Color fundus image — 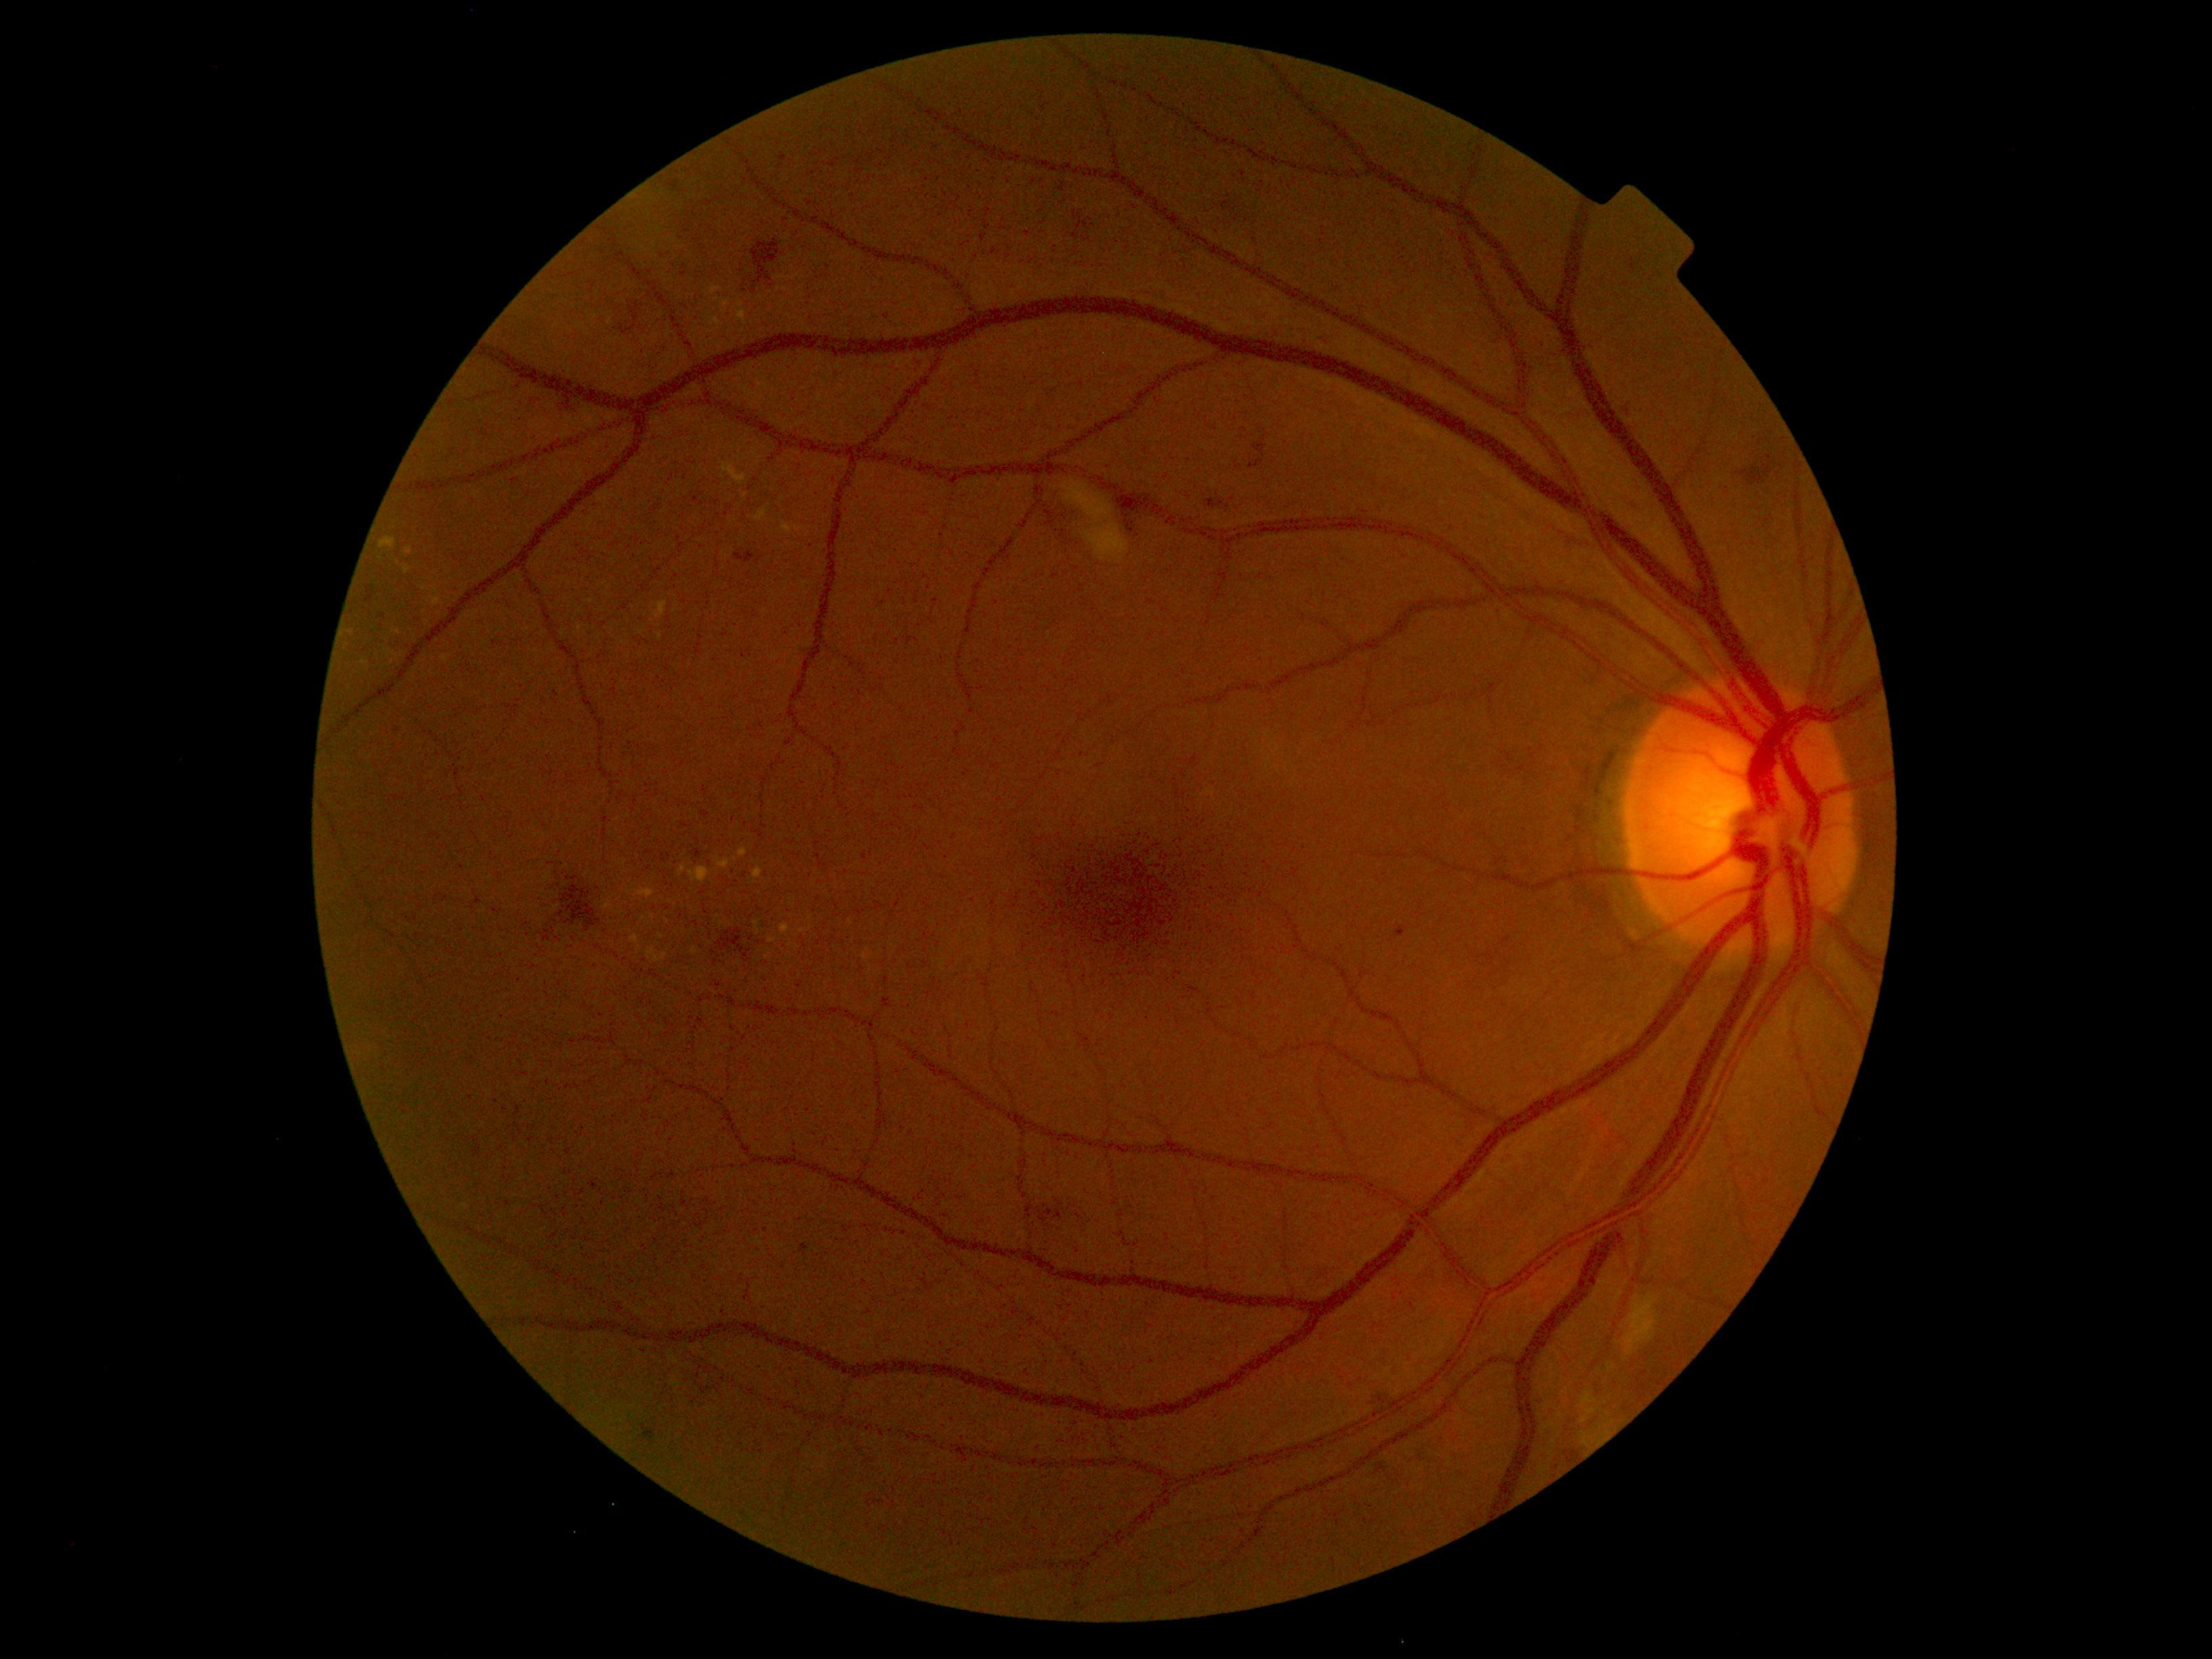 Retinopathy: moderate NPDR (grade 2) — more than just microaneurysms but less than severe NPDR
A subset of detected lesions:
hard exudates (continued): [689,867,716,884]; [783,521,792,535]; [654,602,668,620]; [738,848,747,857]; [720,300,731,315]; [635,888,655,899]; [602,902,612,910]; [391,628,401,635]; [768,939,777,943]; [780,922,790,935]; [711,284,722,303]; [753,921,760,935]; [647,948,668,963]; [719,345,722,353]
Small hard exudates near pt(641, 633); pt(643, 919); pt(659, 637); pt(866, 957); pt(653, 917)